45° field of view
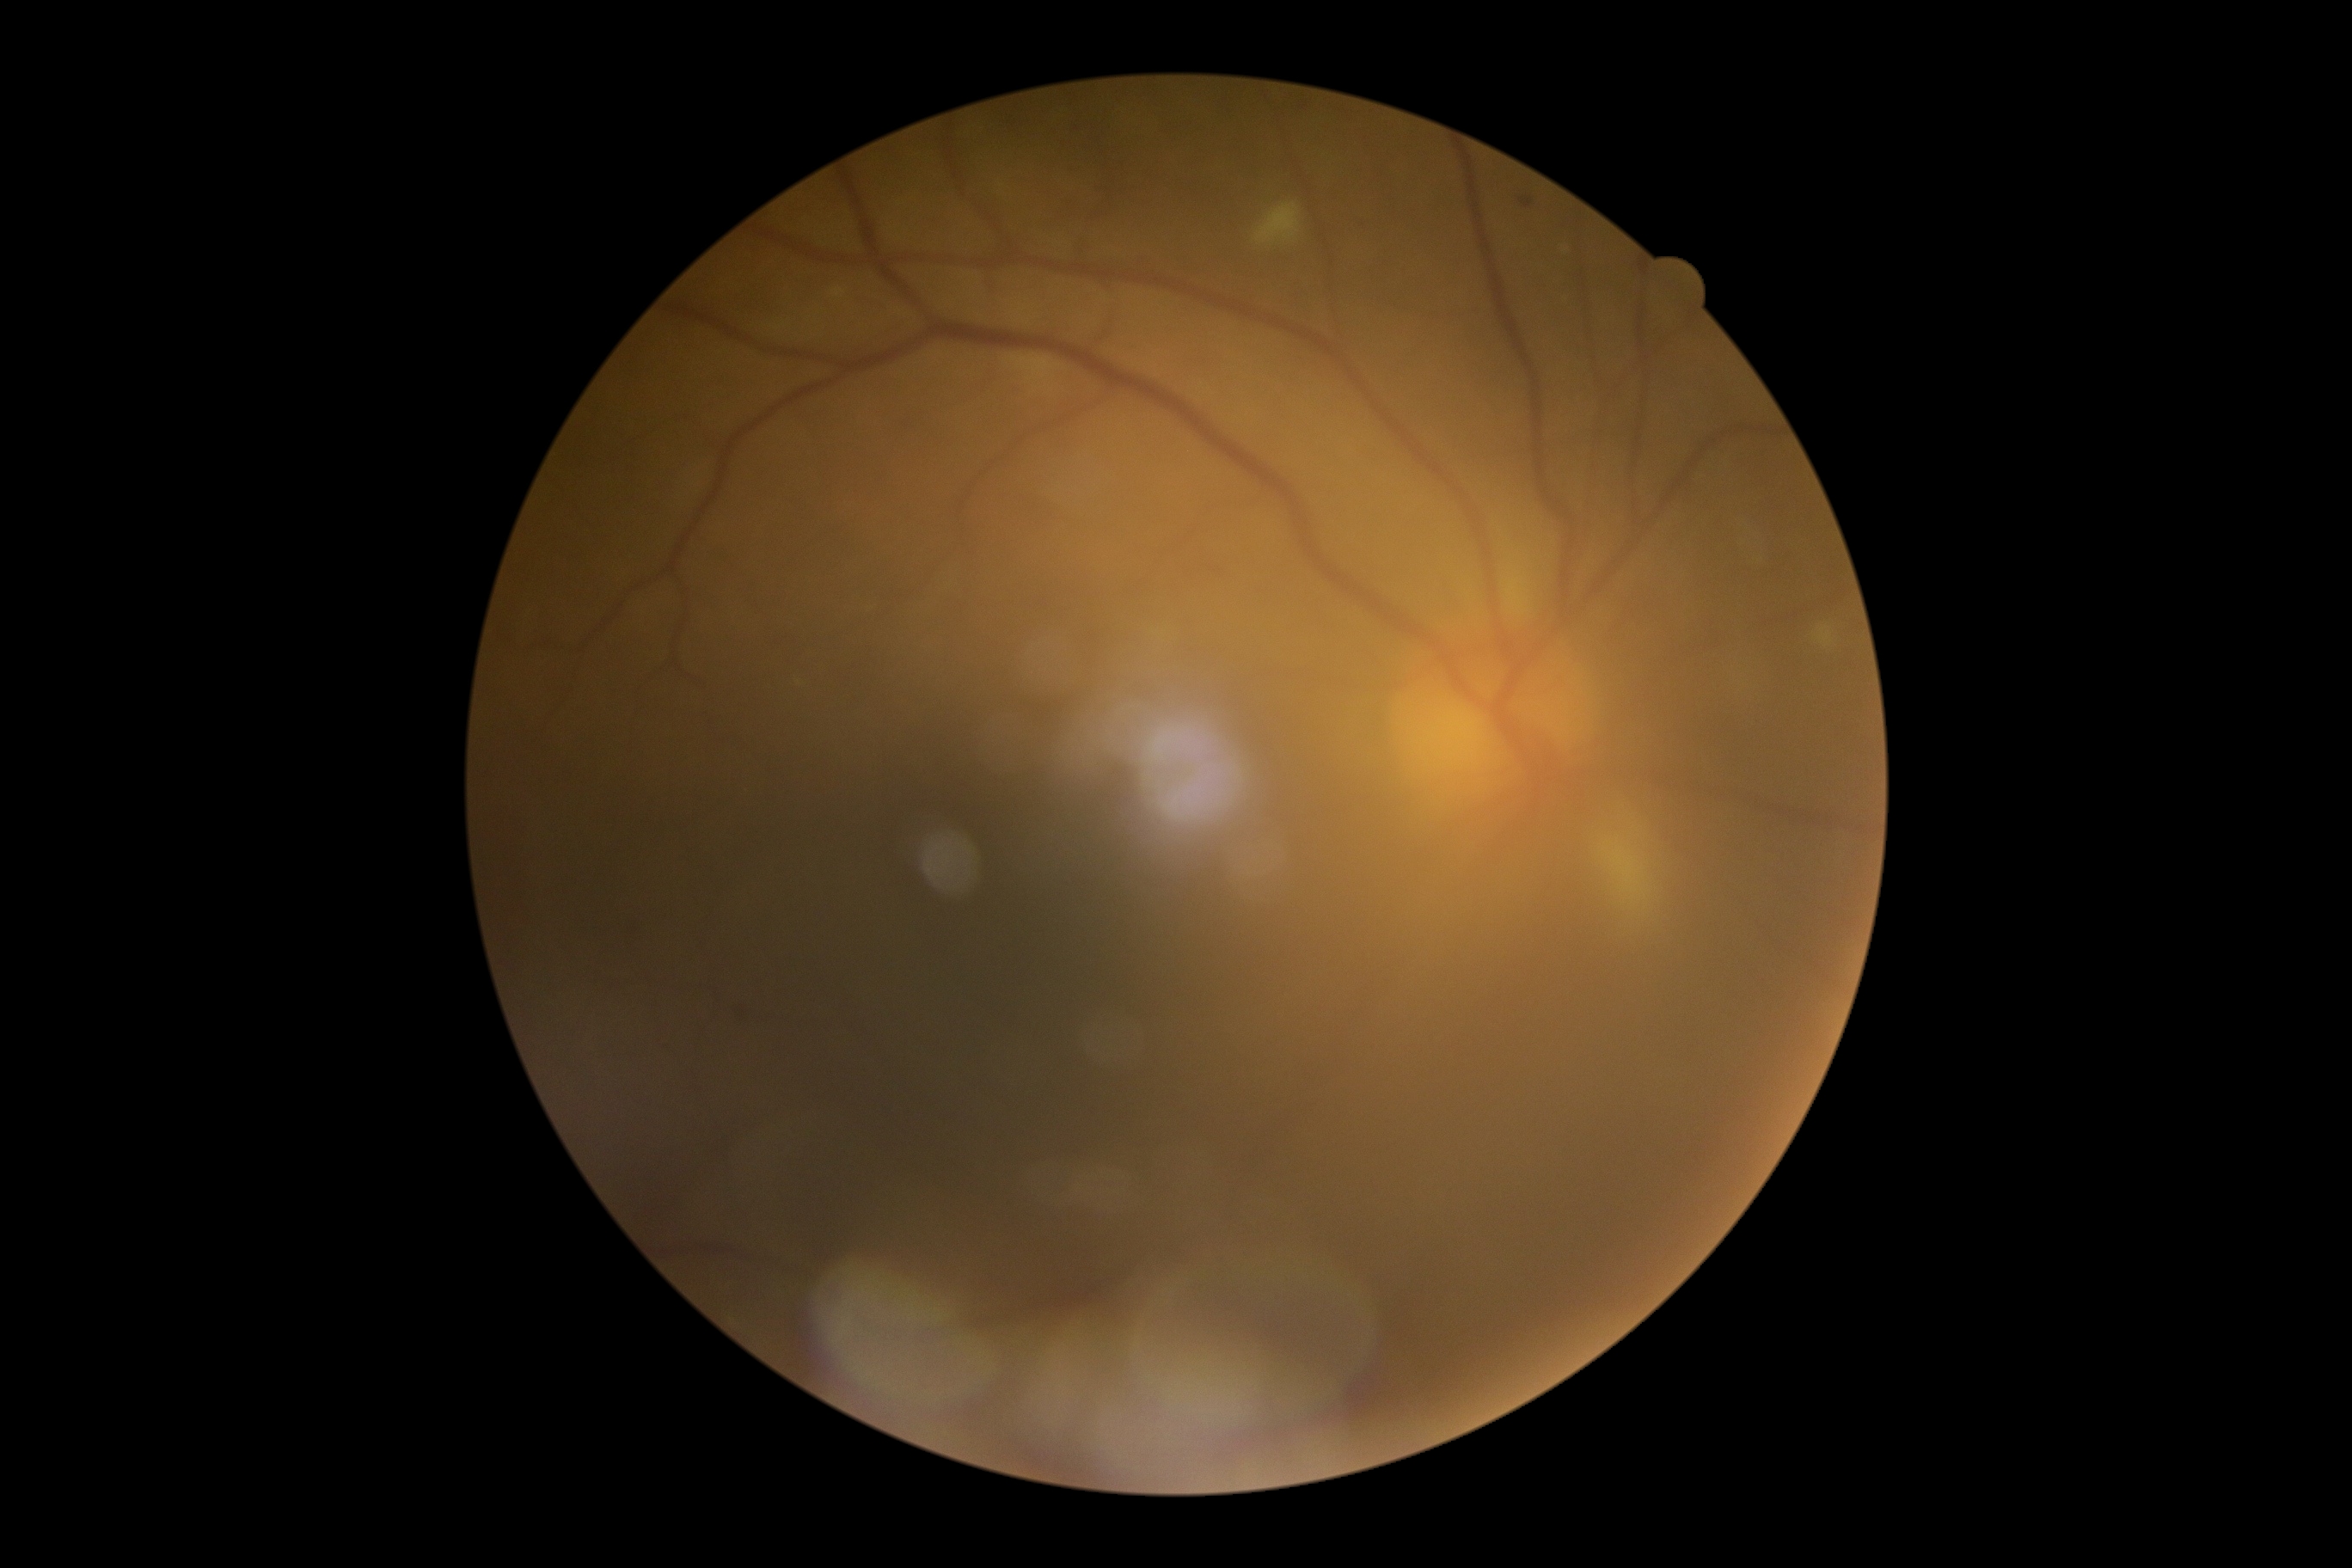

DR: 2/4.